Pediatric wide-field fundus photograph
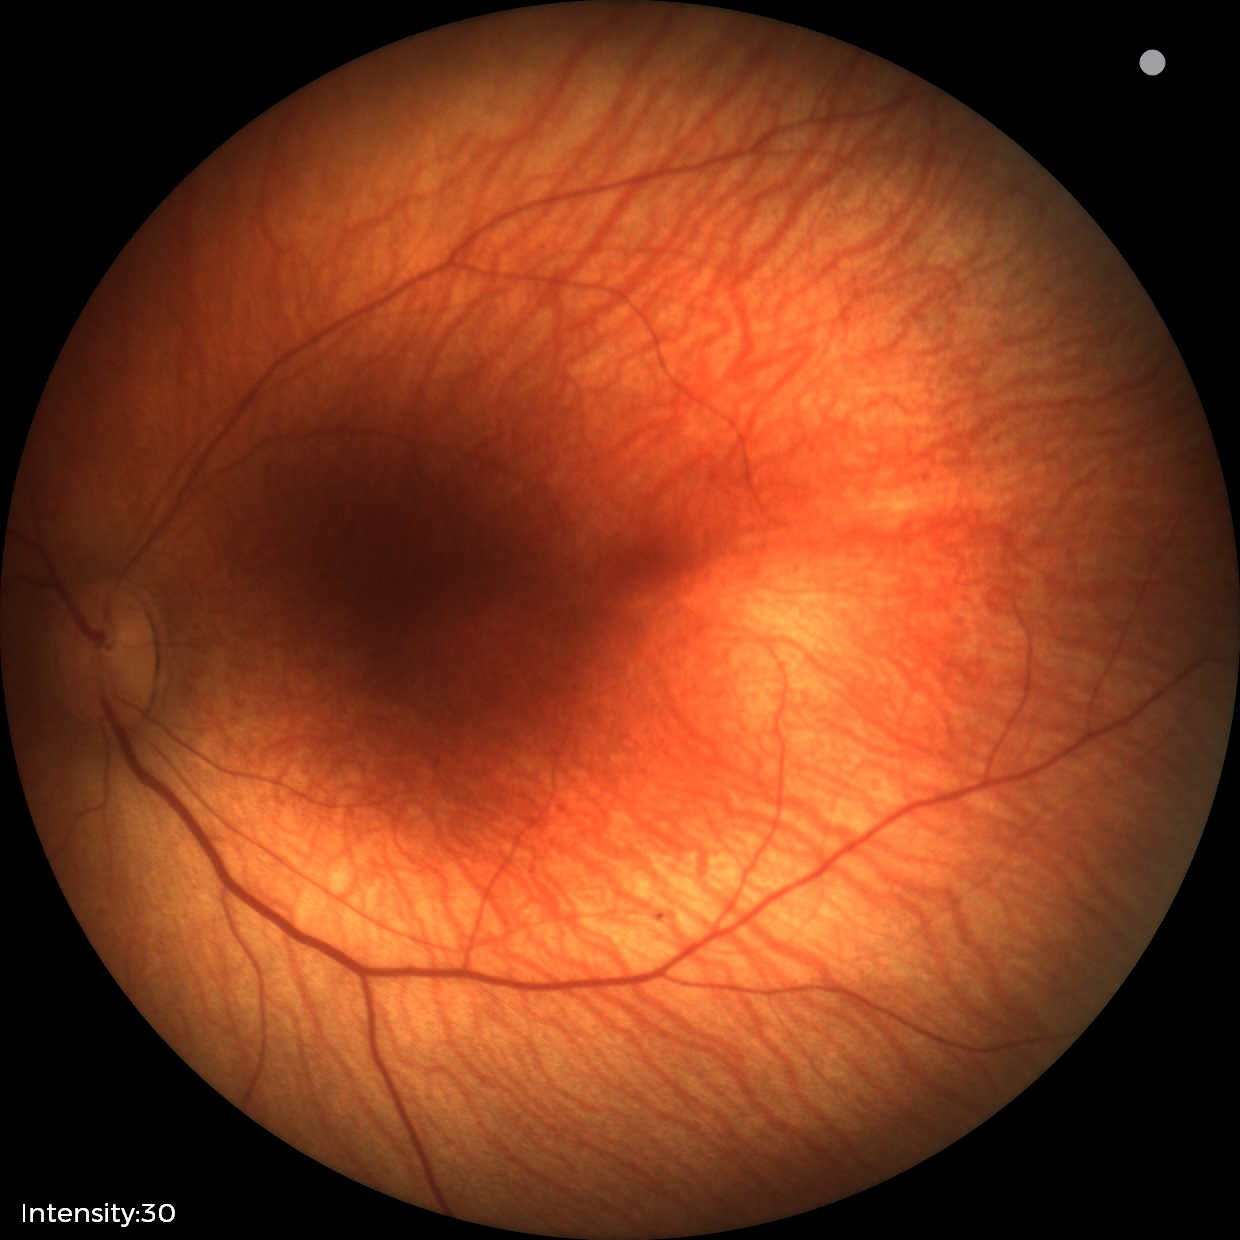
Physiological retinal appearance for postconceptual age.